Phoenix ICON wide-field infant fundus image; 1240 by 1240 pixels; captured with the Phoenix ICON (100° field of view)
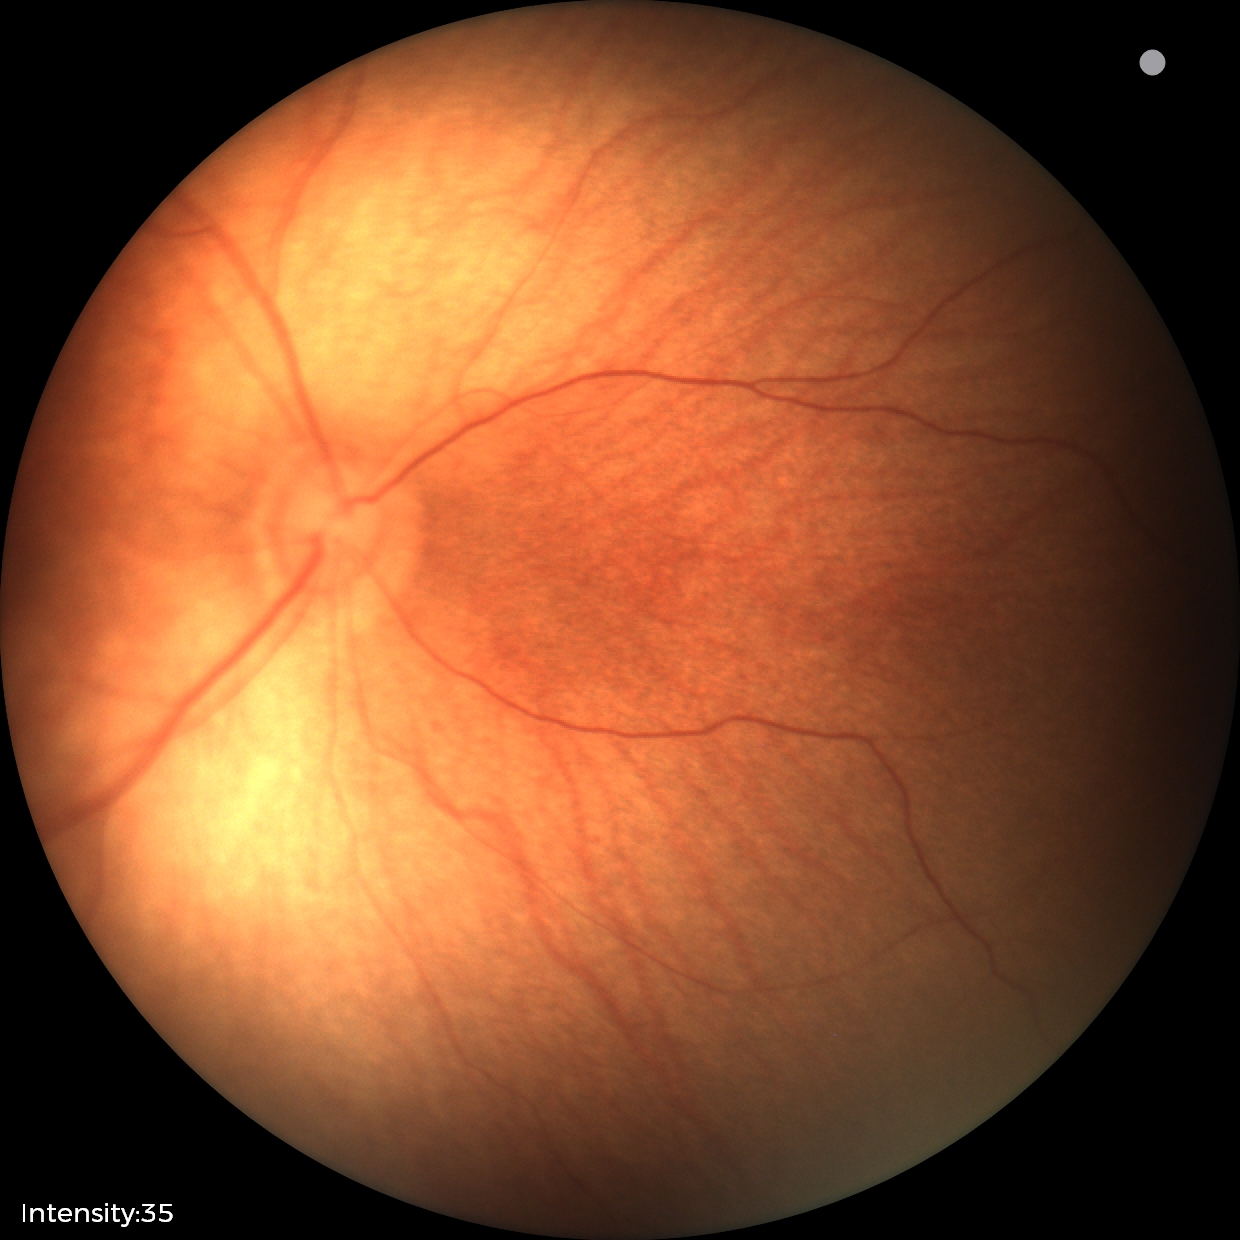 Examination with physiological retinal findings.